Modified Davis grading. NIDEK AFC-230
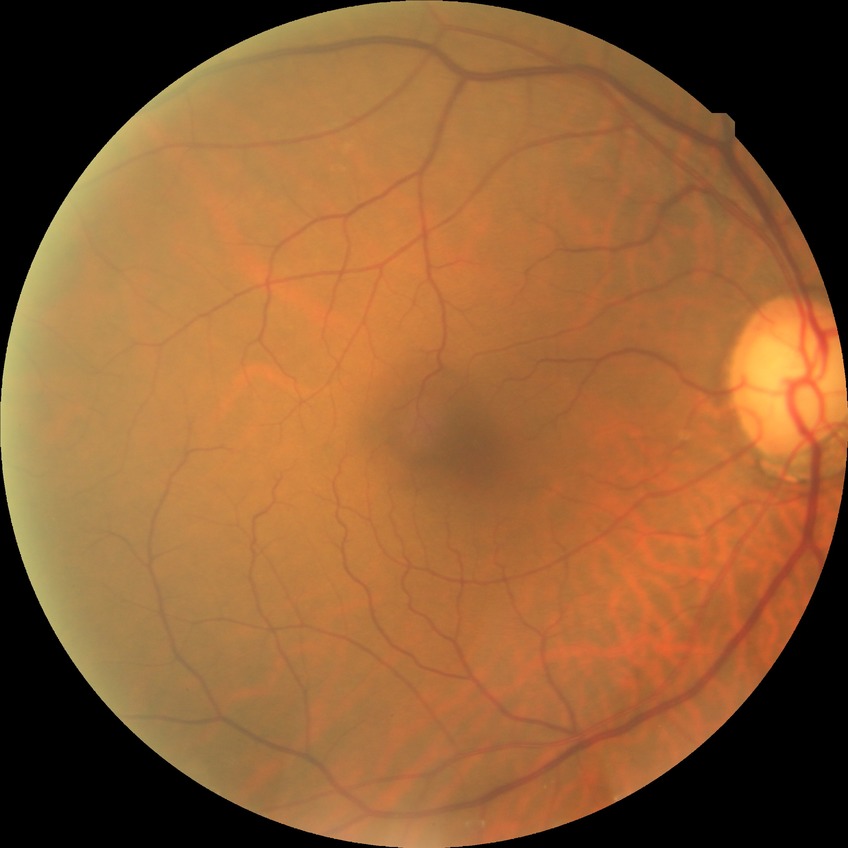
Findings:
* diabetic retinopathy (DR) — no diabetic retinopathy (NDR)